Retinal fundus photograph; 2184 x 1690 pixels.
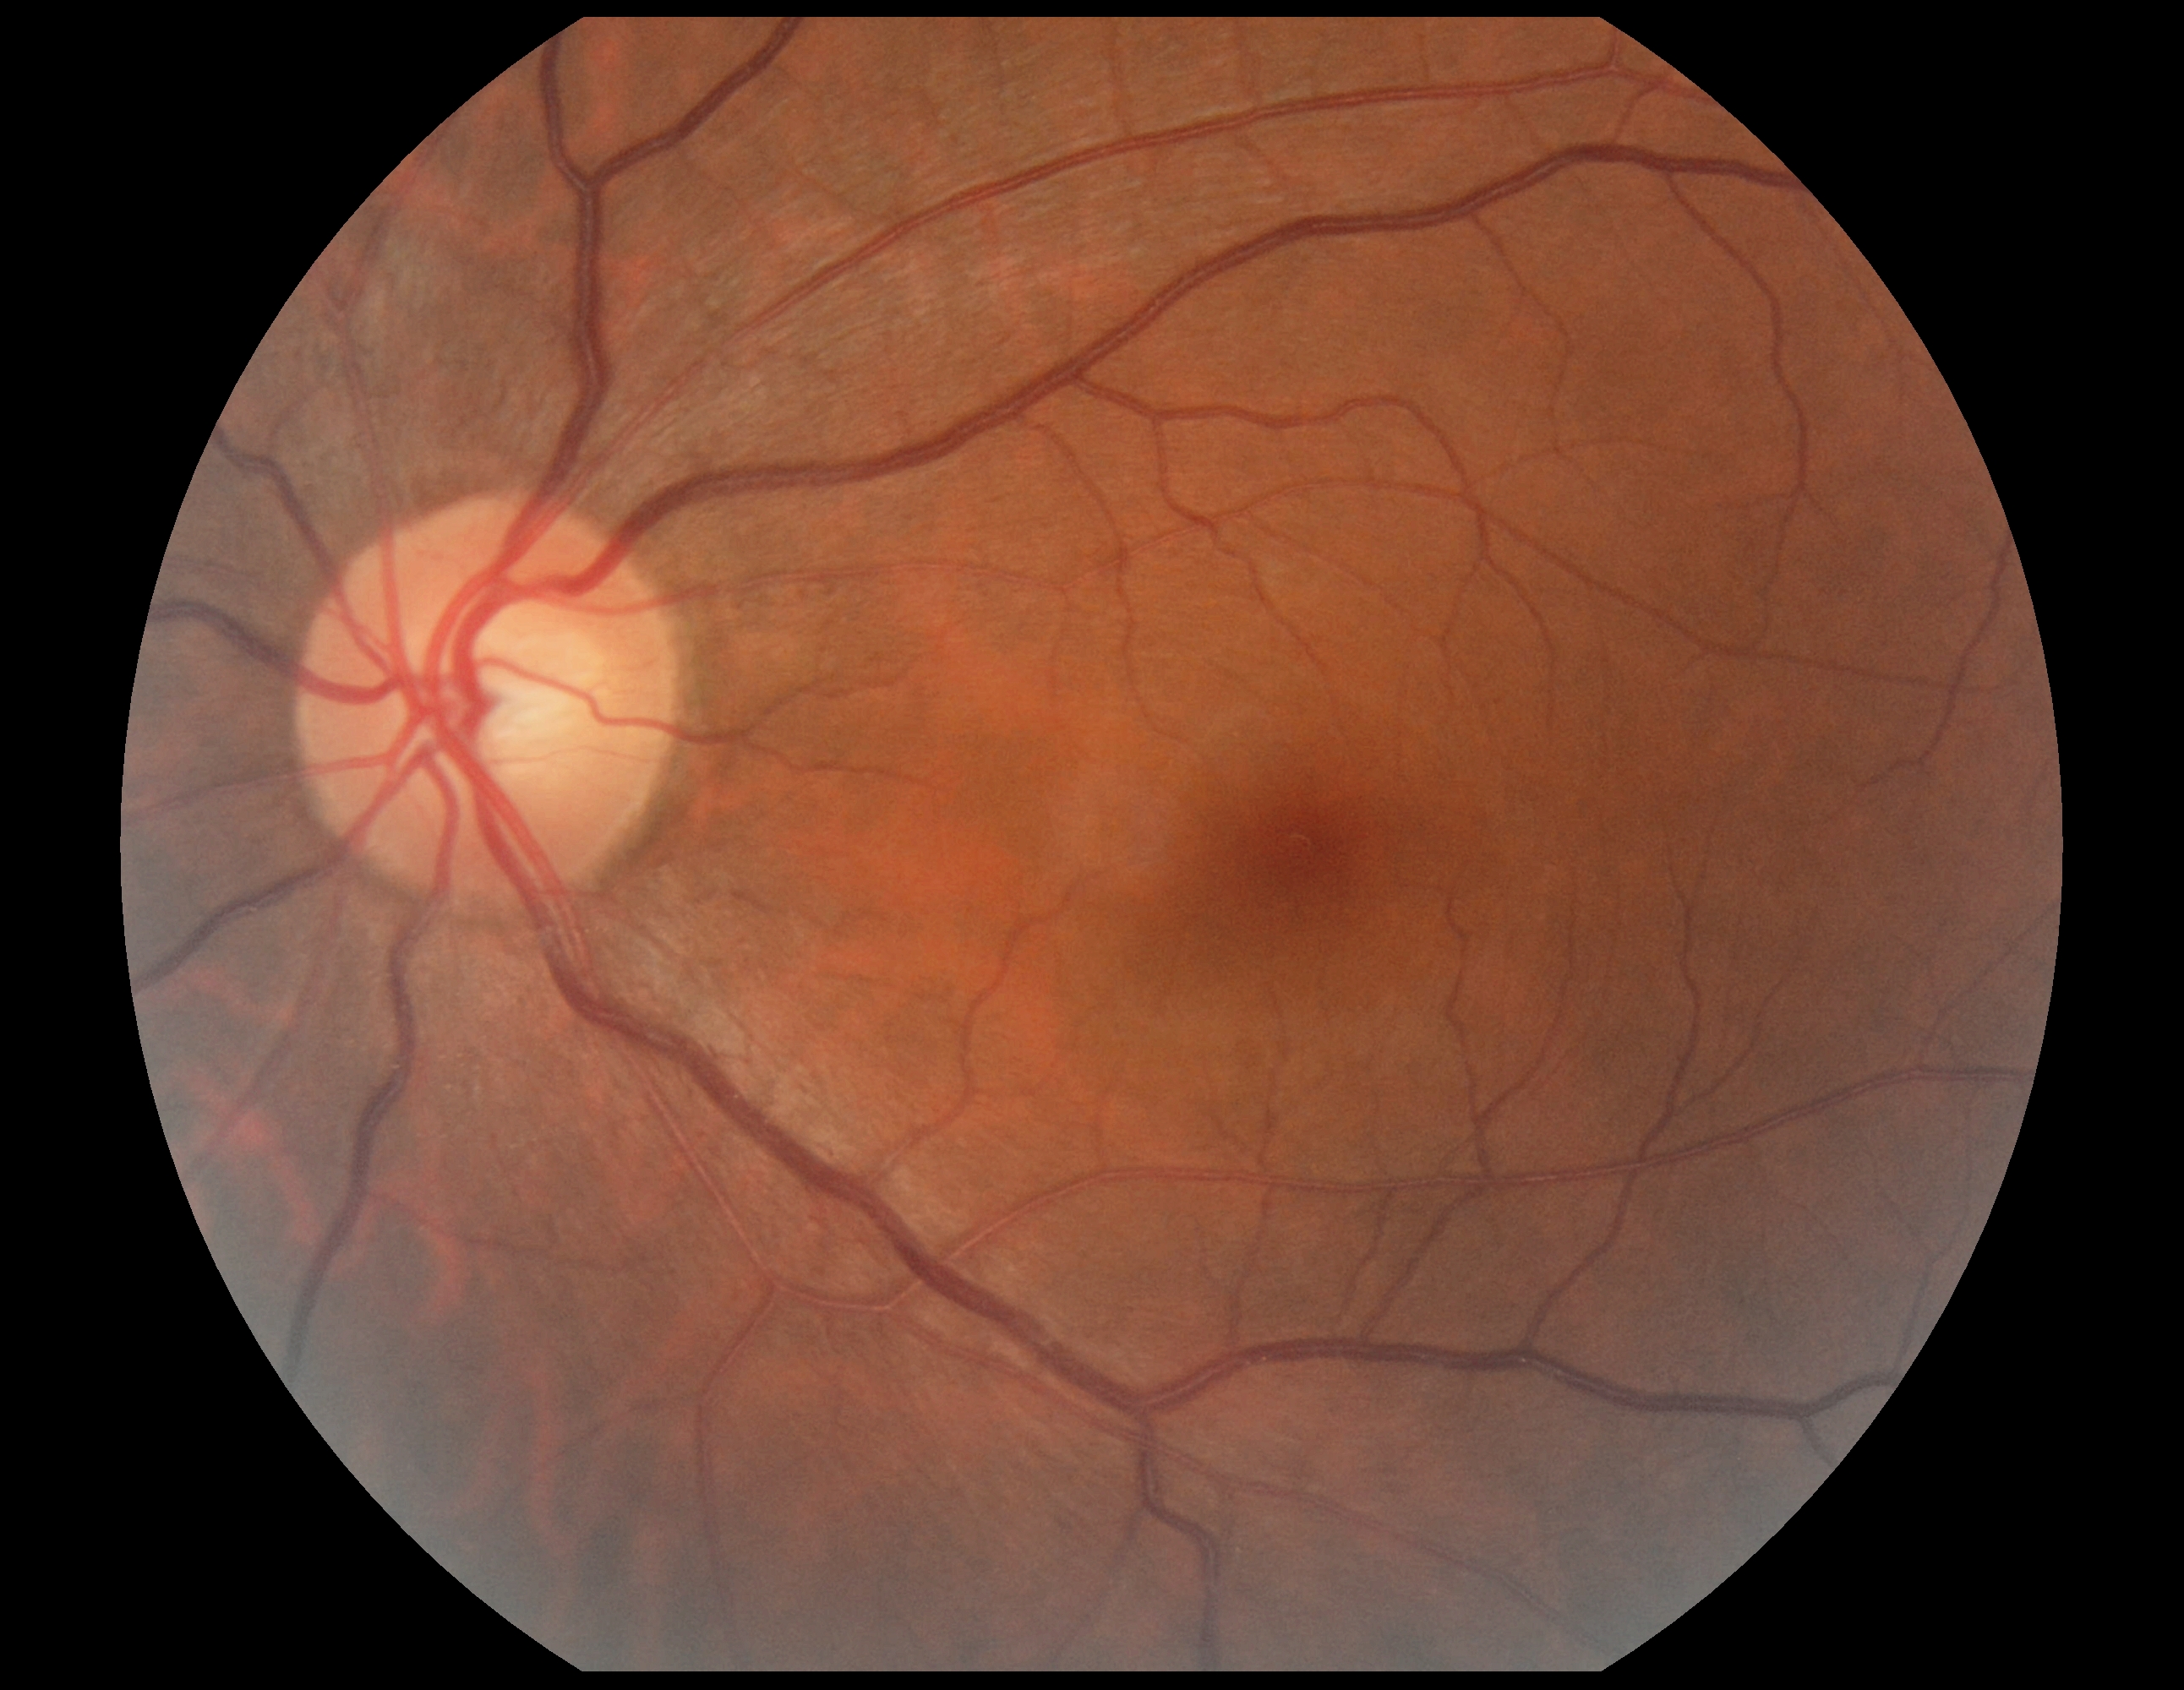 dr_impression: no signs of DR
dr_grade: no apparent diabetic retinopathy (grade 0) — no visible signs of diabetic retinopathy